Modified Davis grading; 45° field of view; posterior pole color fundus photograph
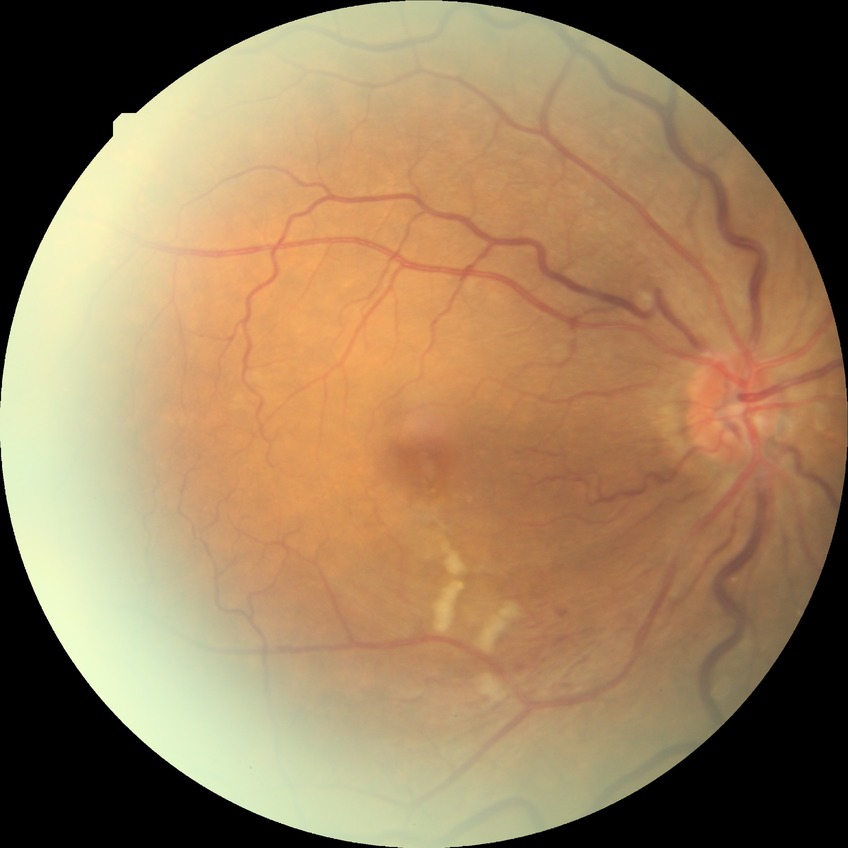

Modified Davis grade: NDR.